Nonmydriatic, 45-degree field of view, 848x848 — 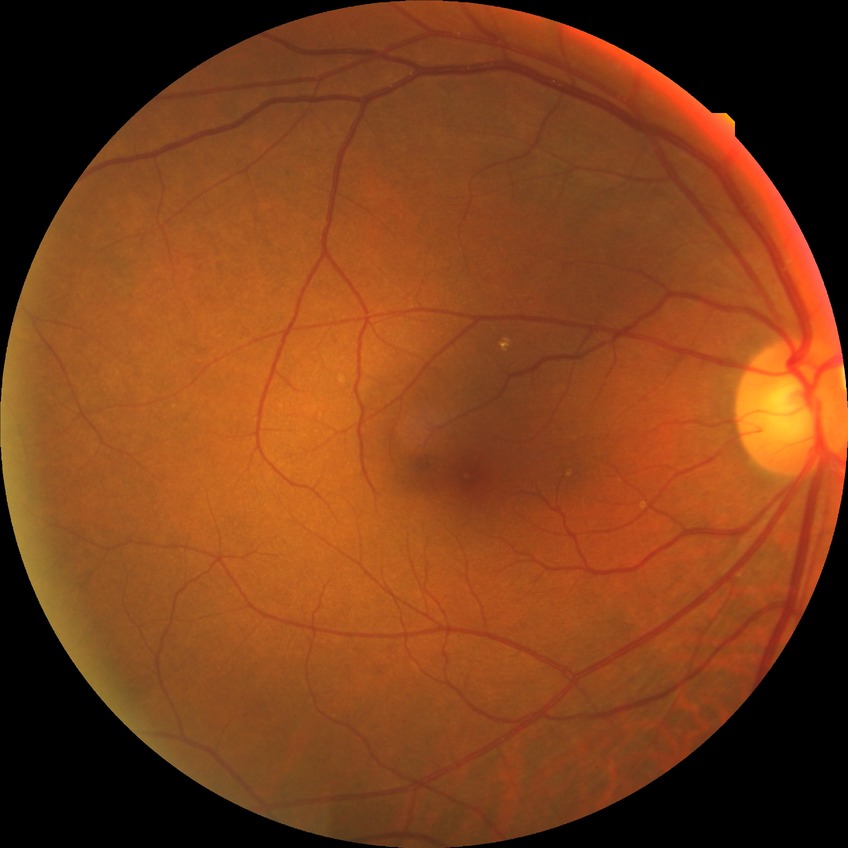

Davis grade: NDR.